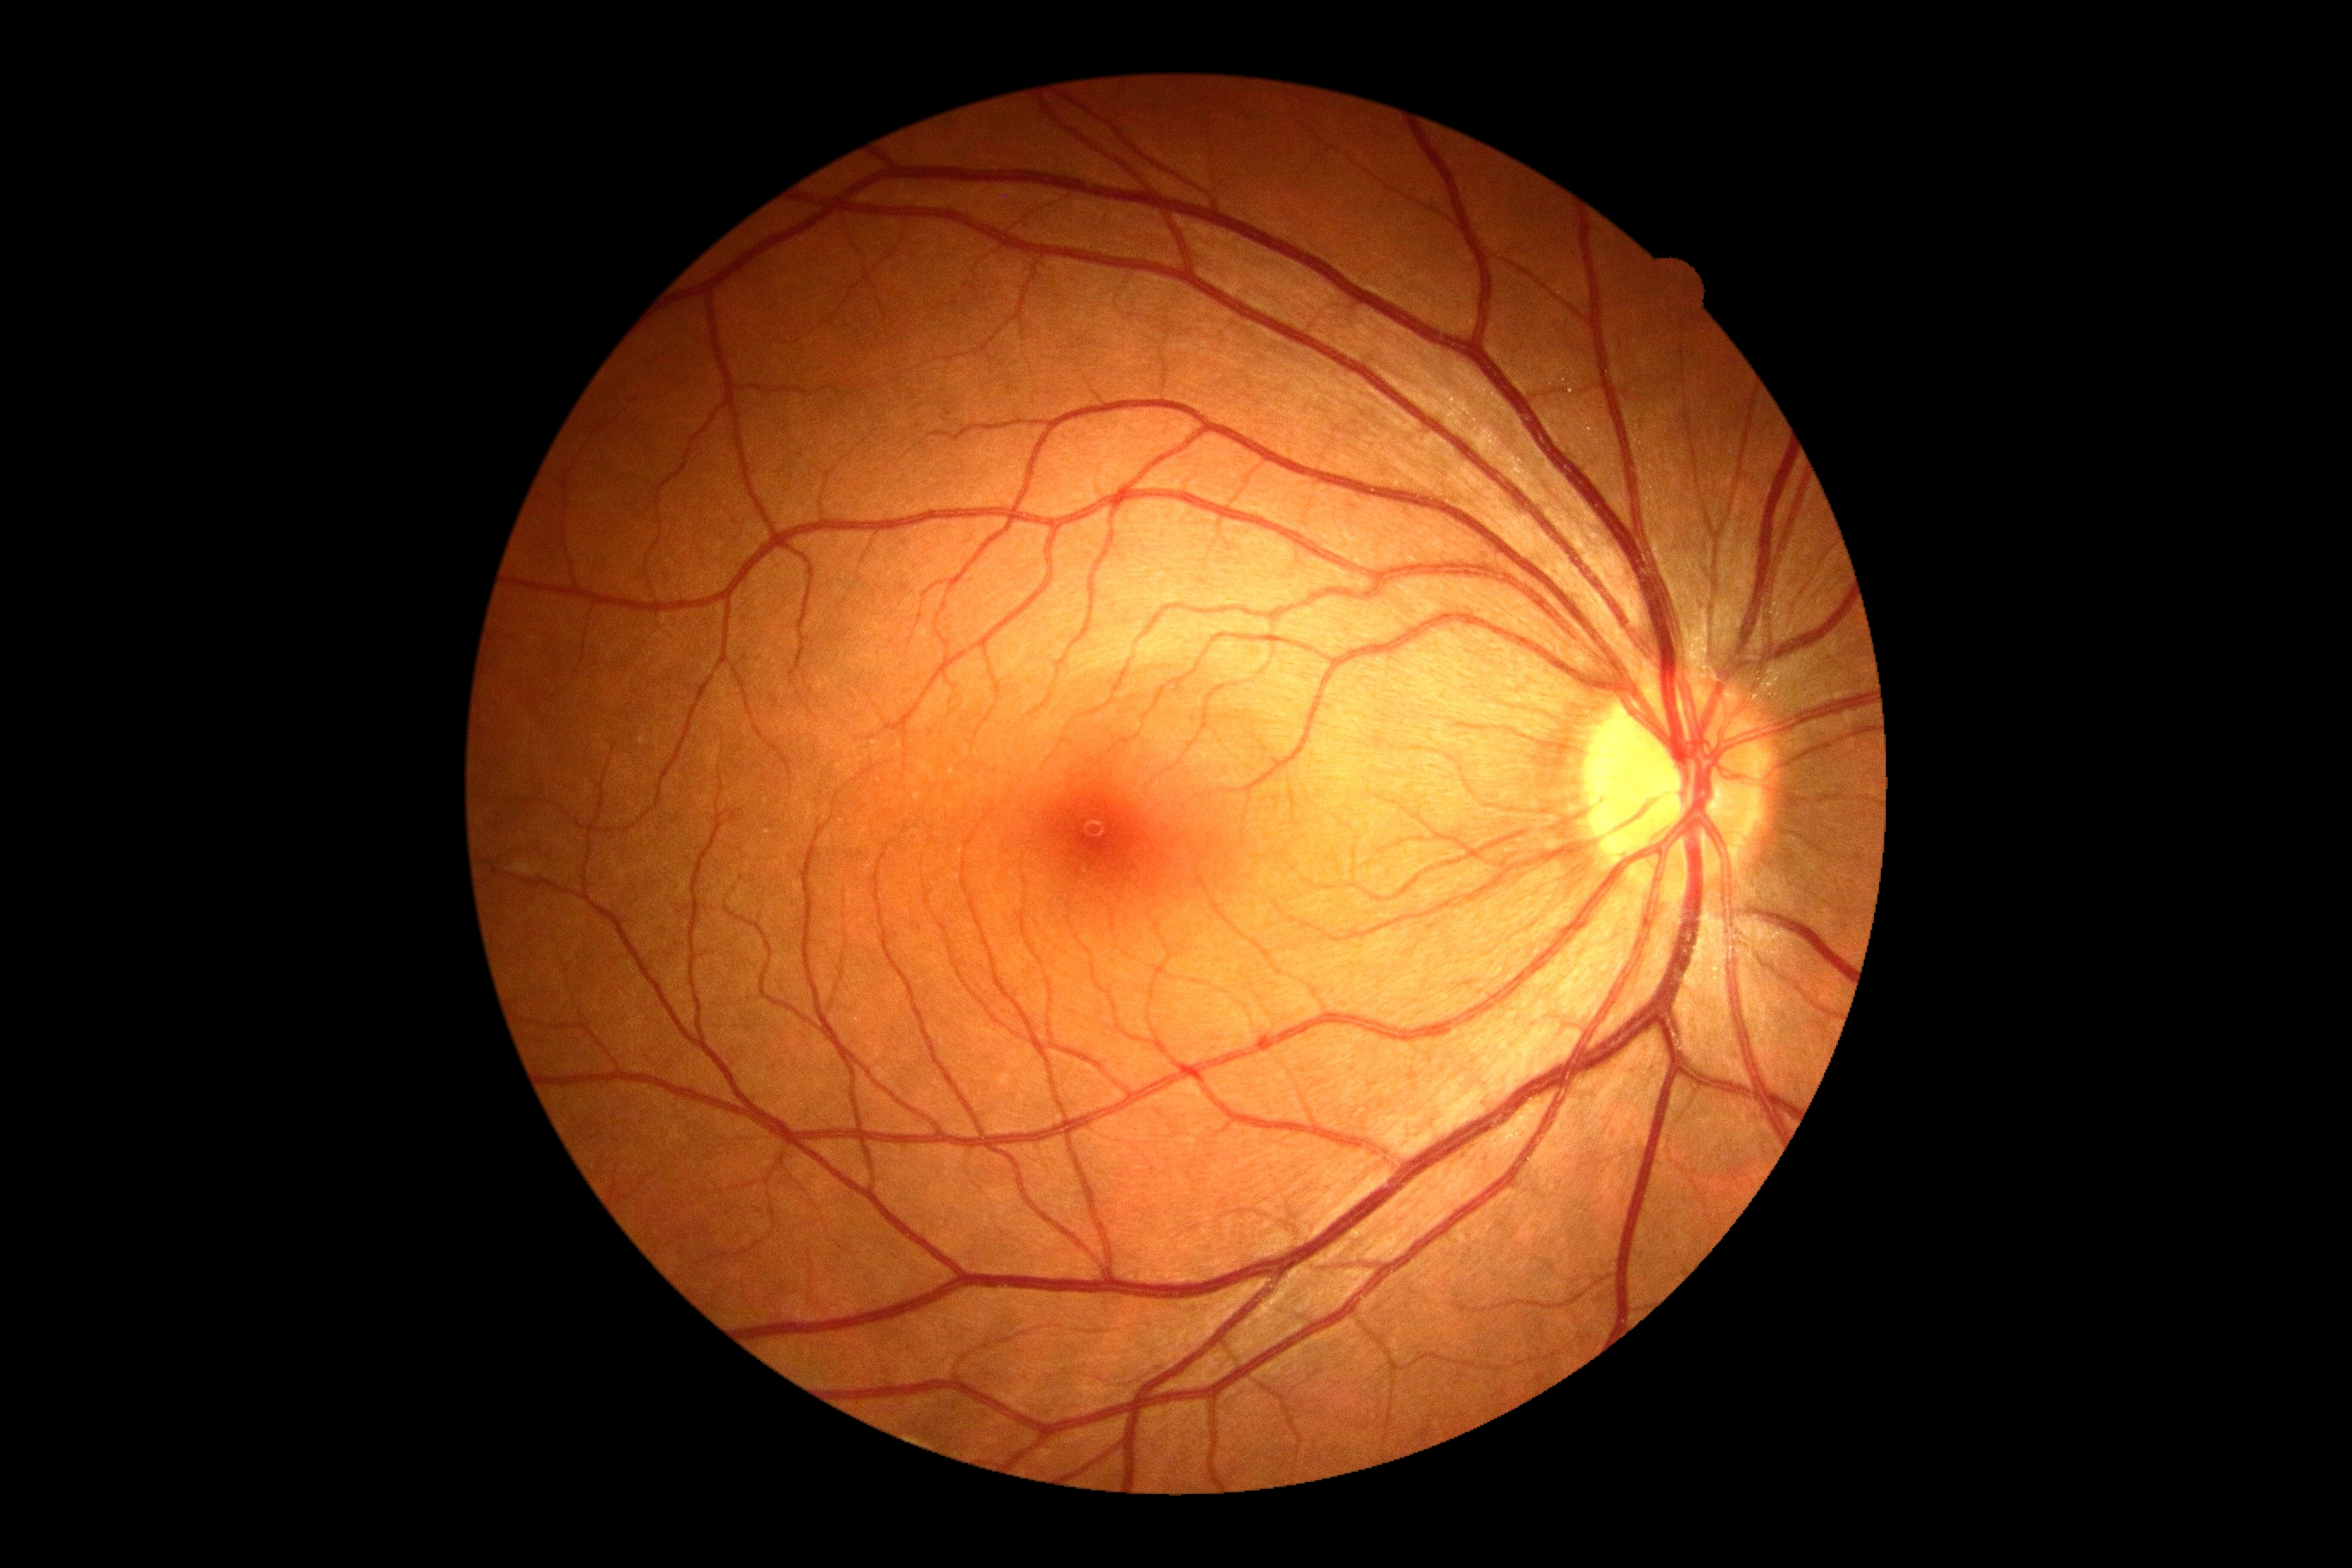
Retinopathy grade is 0 — no visible signs of diabetic retinopathy. No diabetic retinal disease findings.